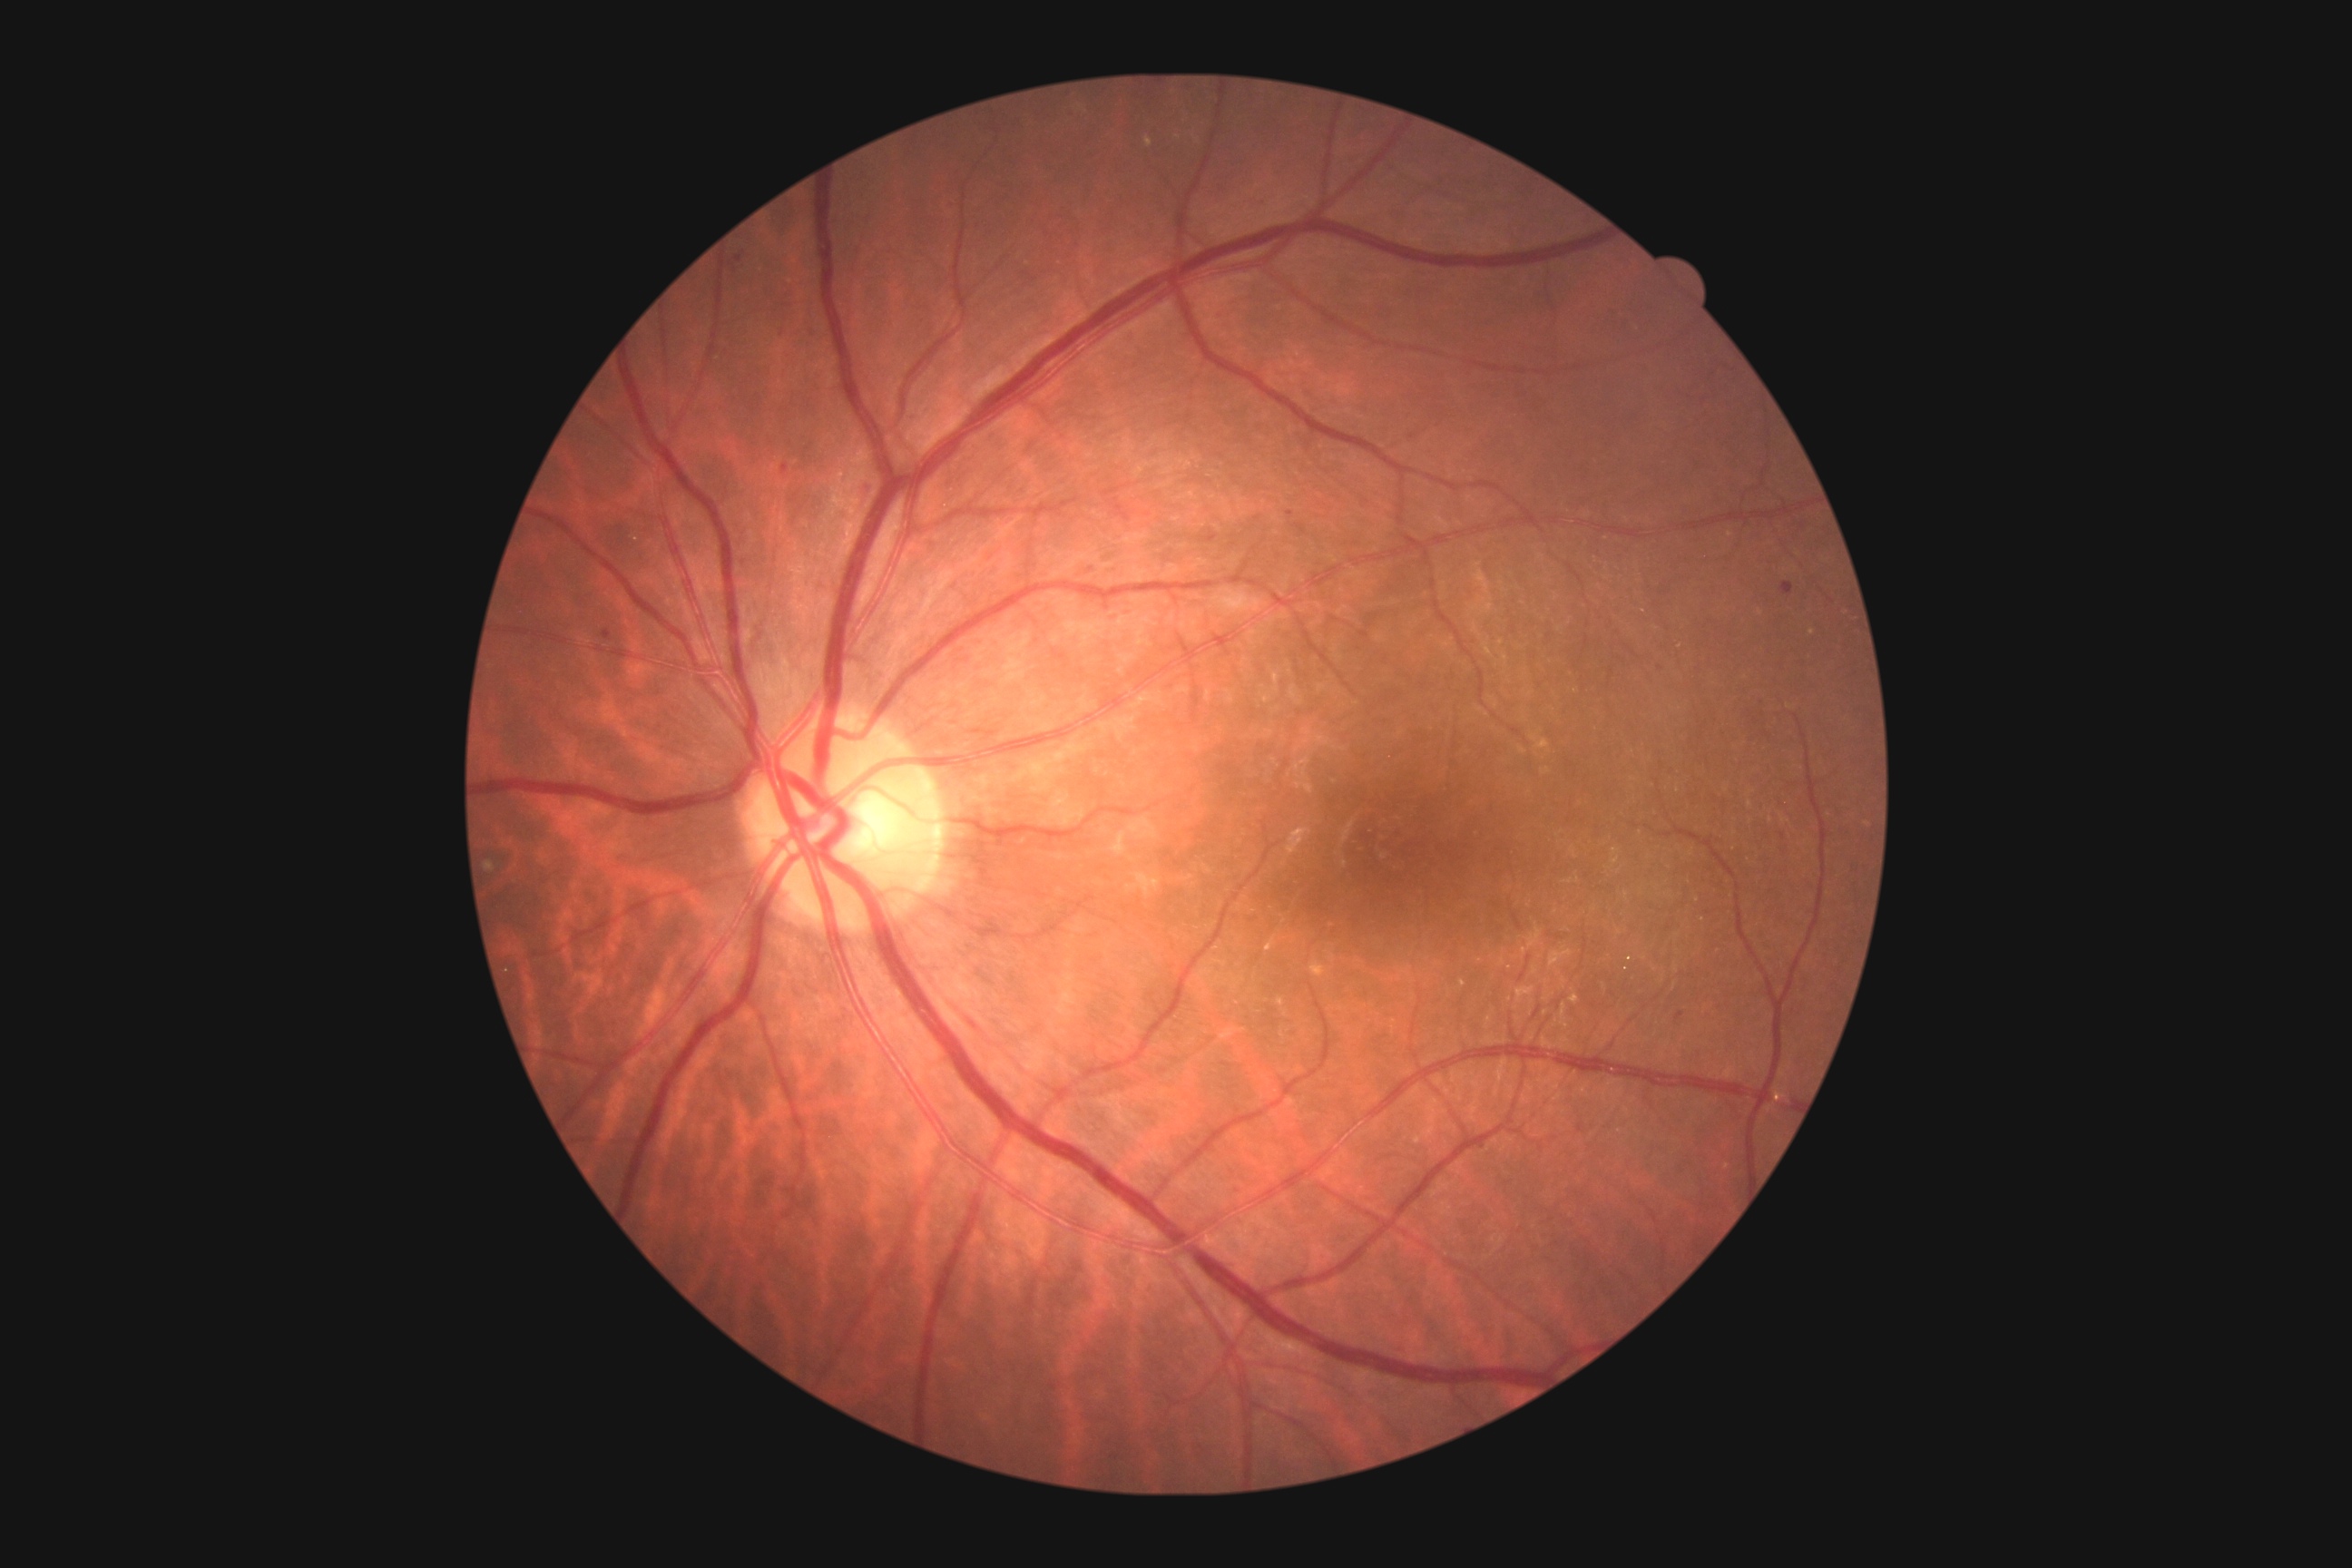   dr_grade: moderate NPDR (grade 2)